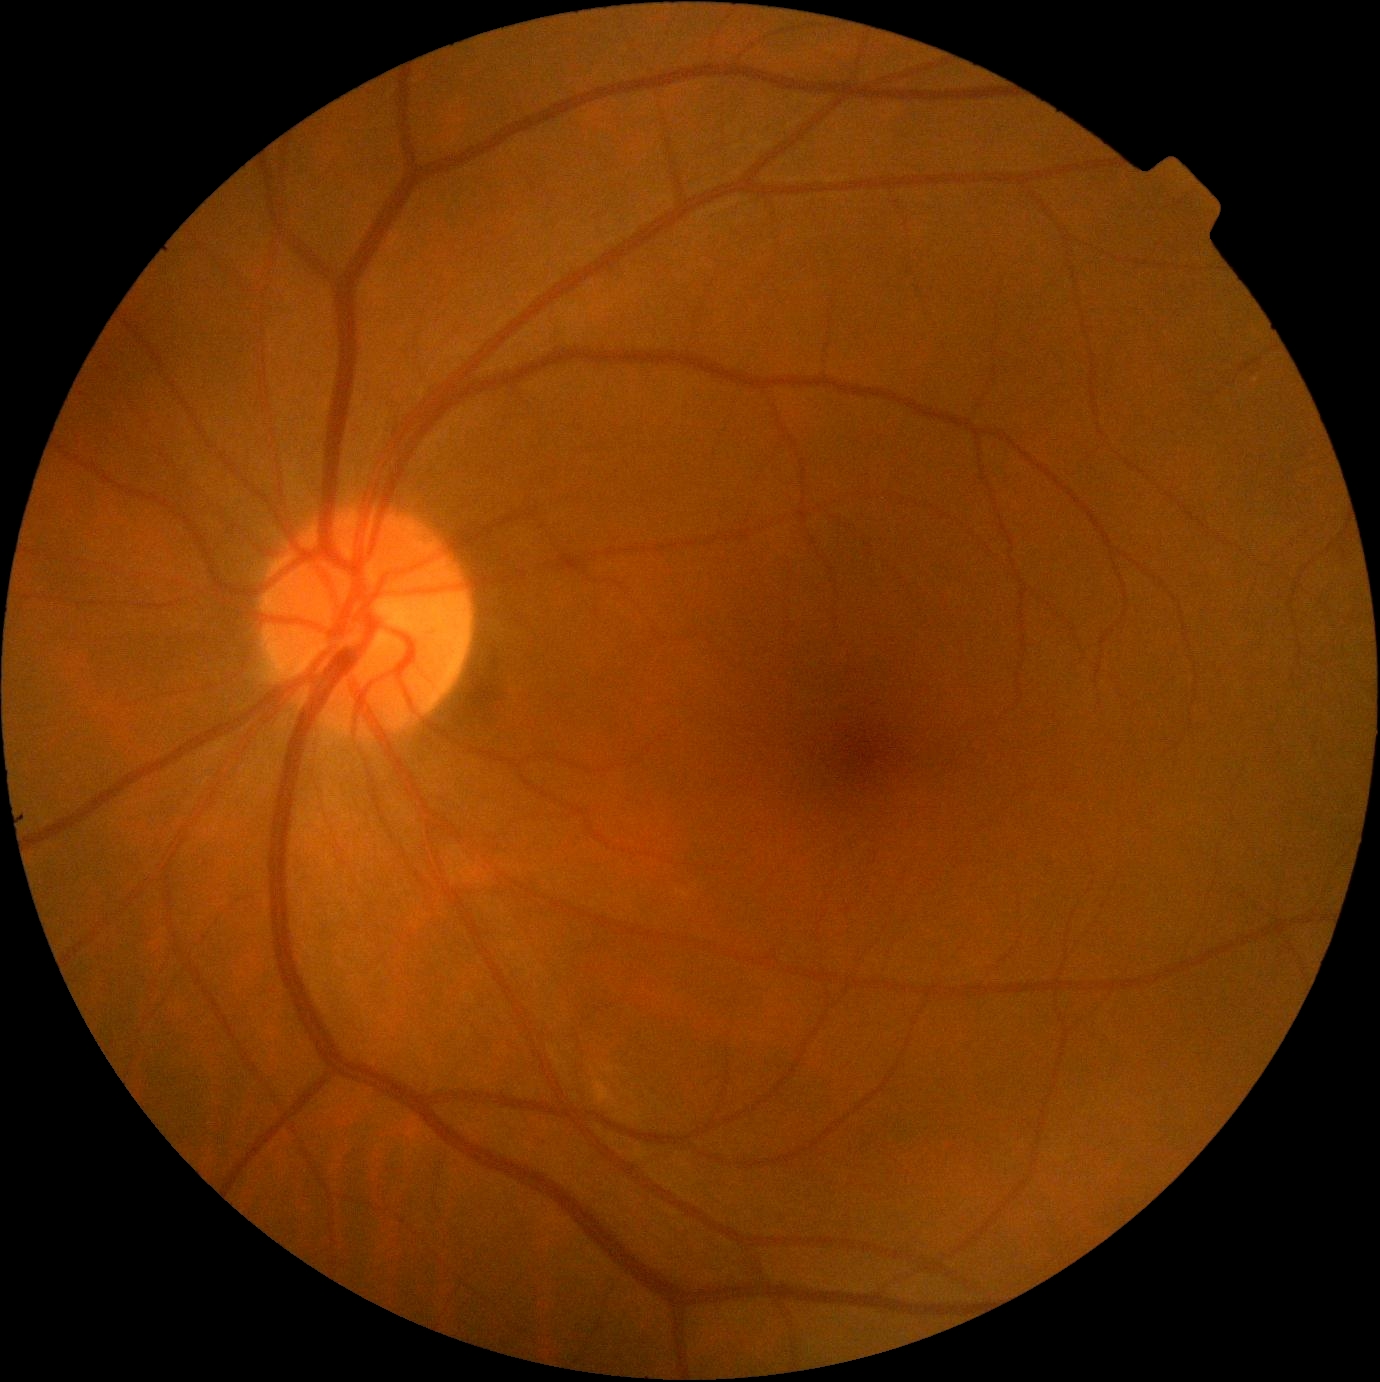
Diabetic retinopathy grade is 0 (no apparent retinopathy).